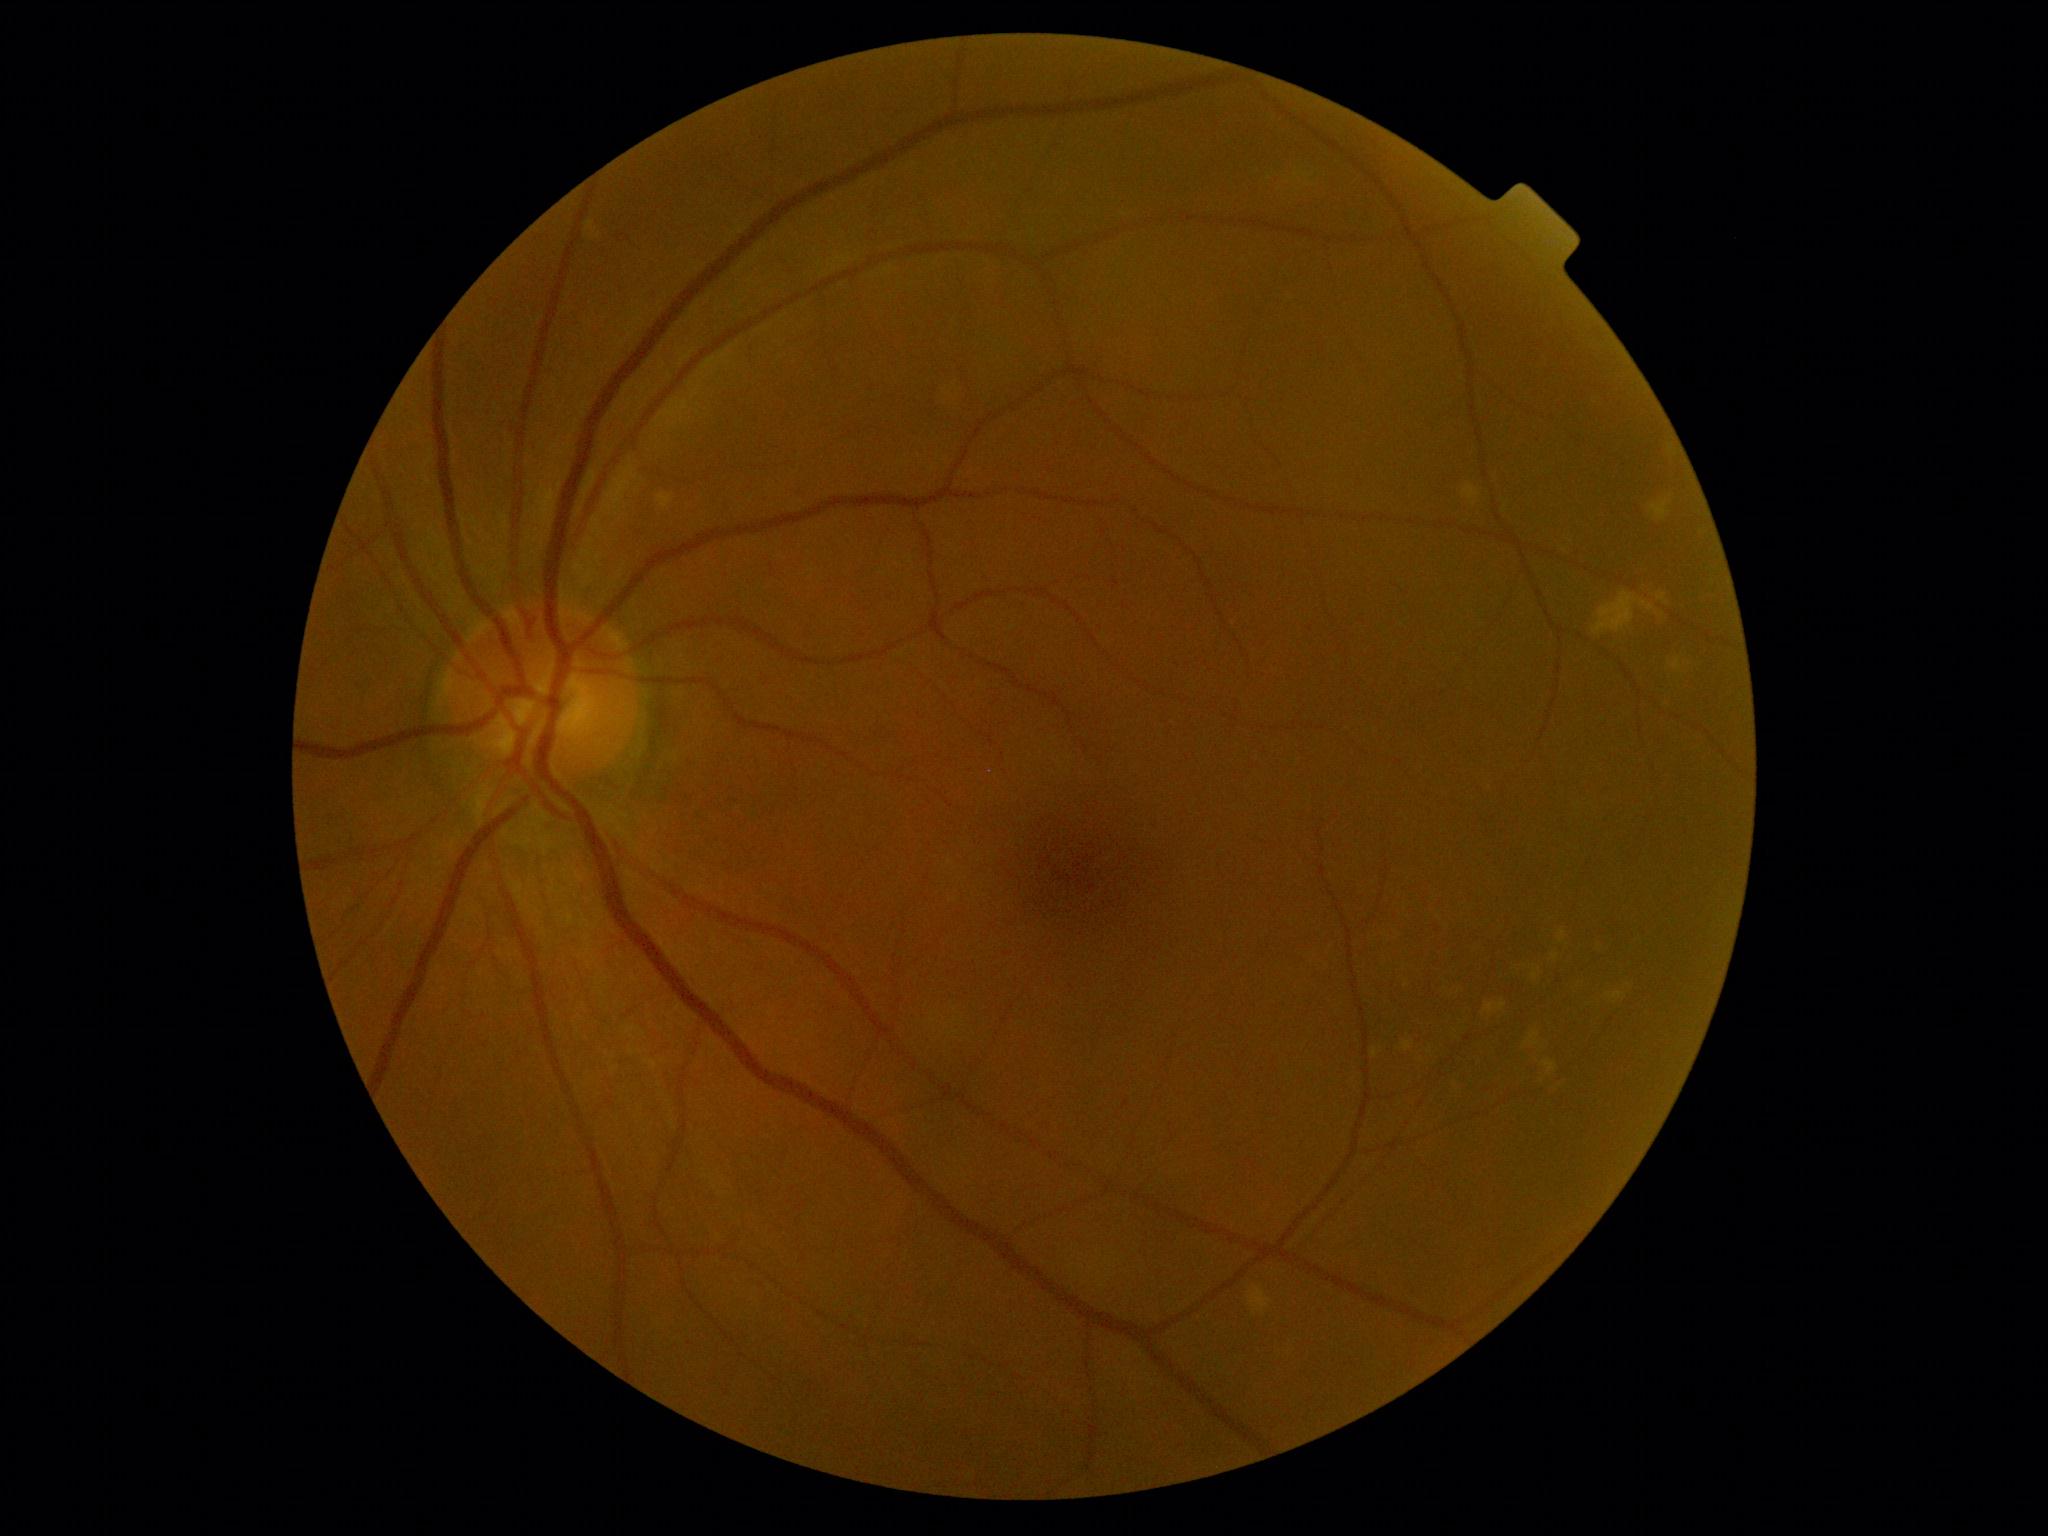
No apparent diabetic retinopathy. DR severity: 0.